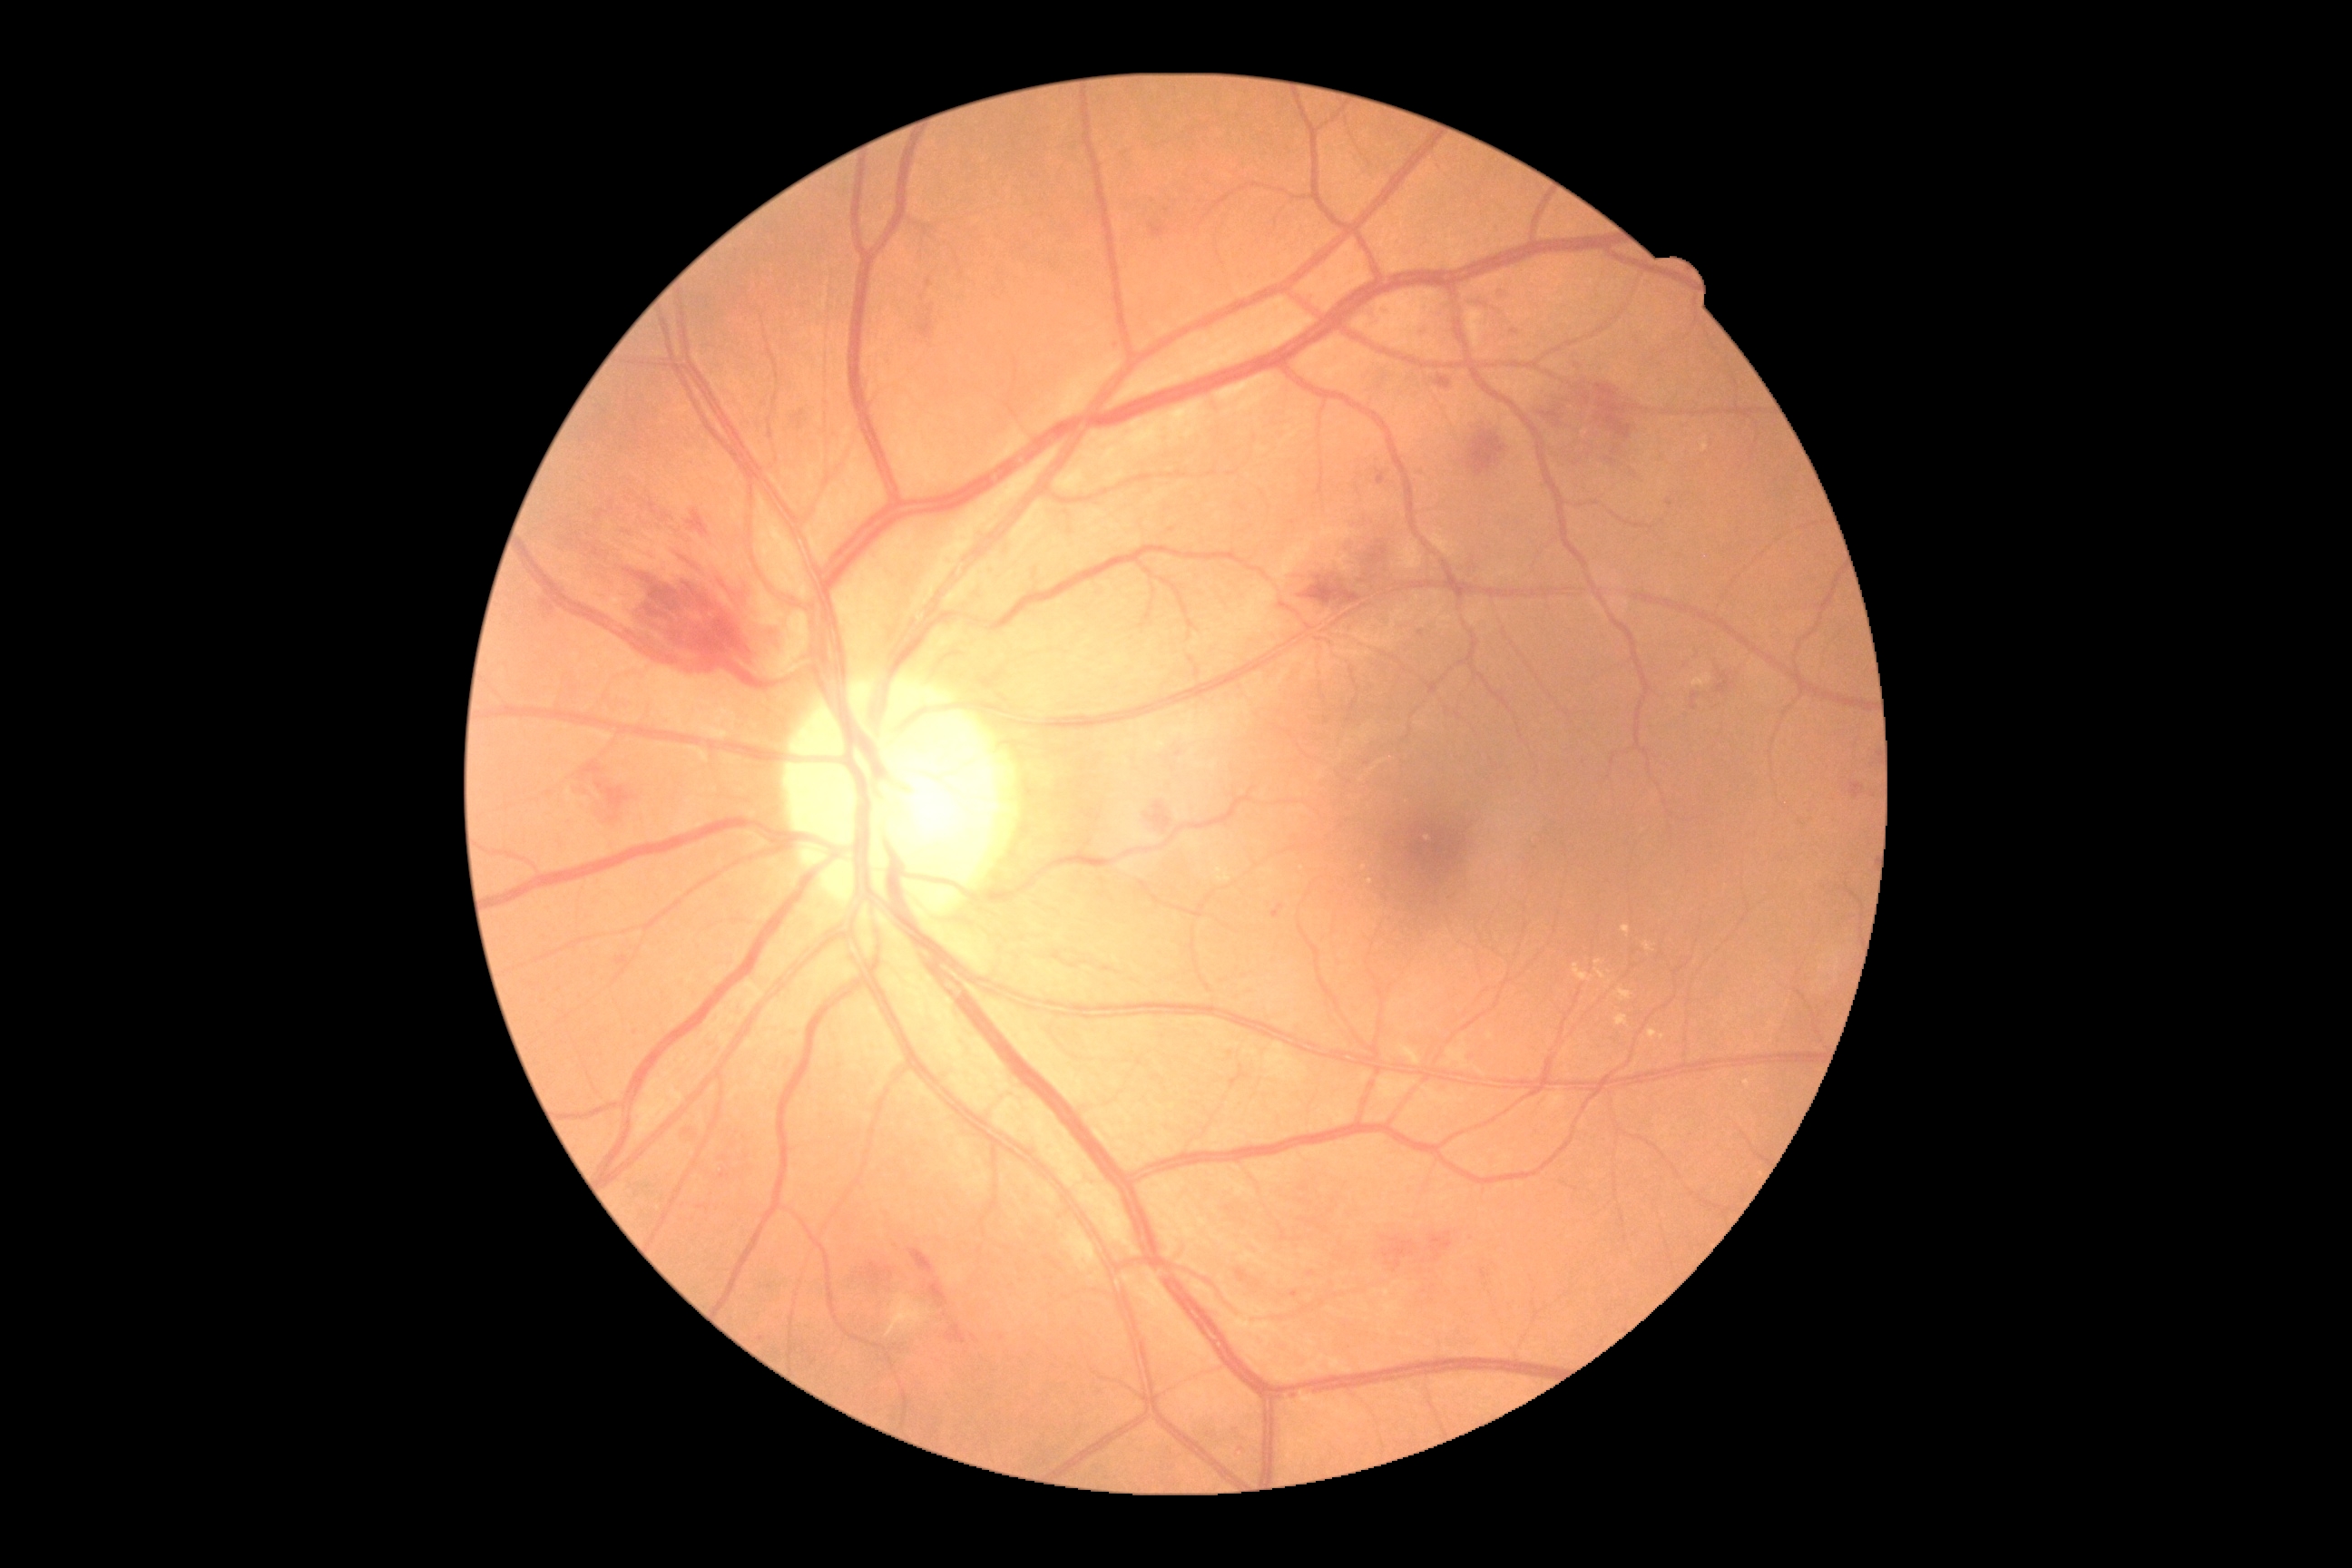
DR stage is grade 2 (moderate NPDR) — more than just microaneurysms but less than severe NPDR.